Posterior pole color fundus photograph, 848 by 848 pixels, 45° FOV, modified Davis classification.
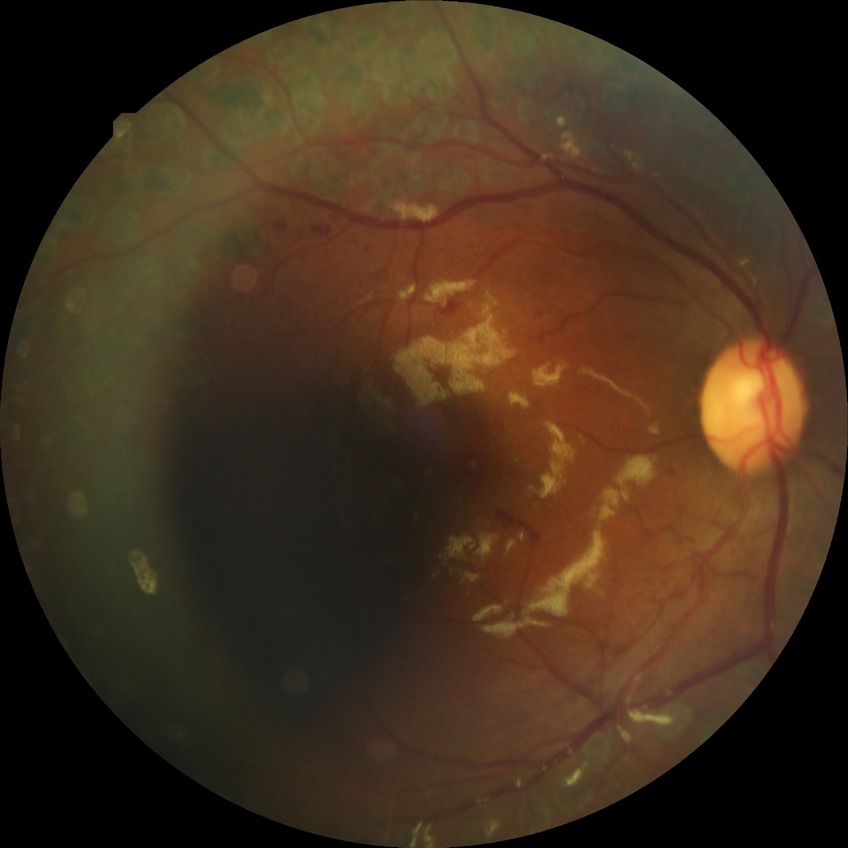
Modified Davis grading is proliferative diabetic retinopathy.